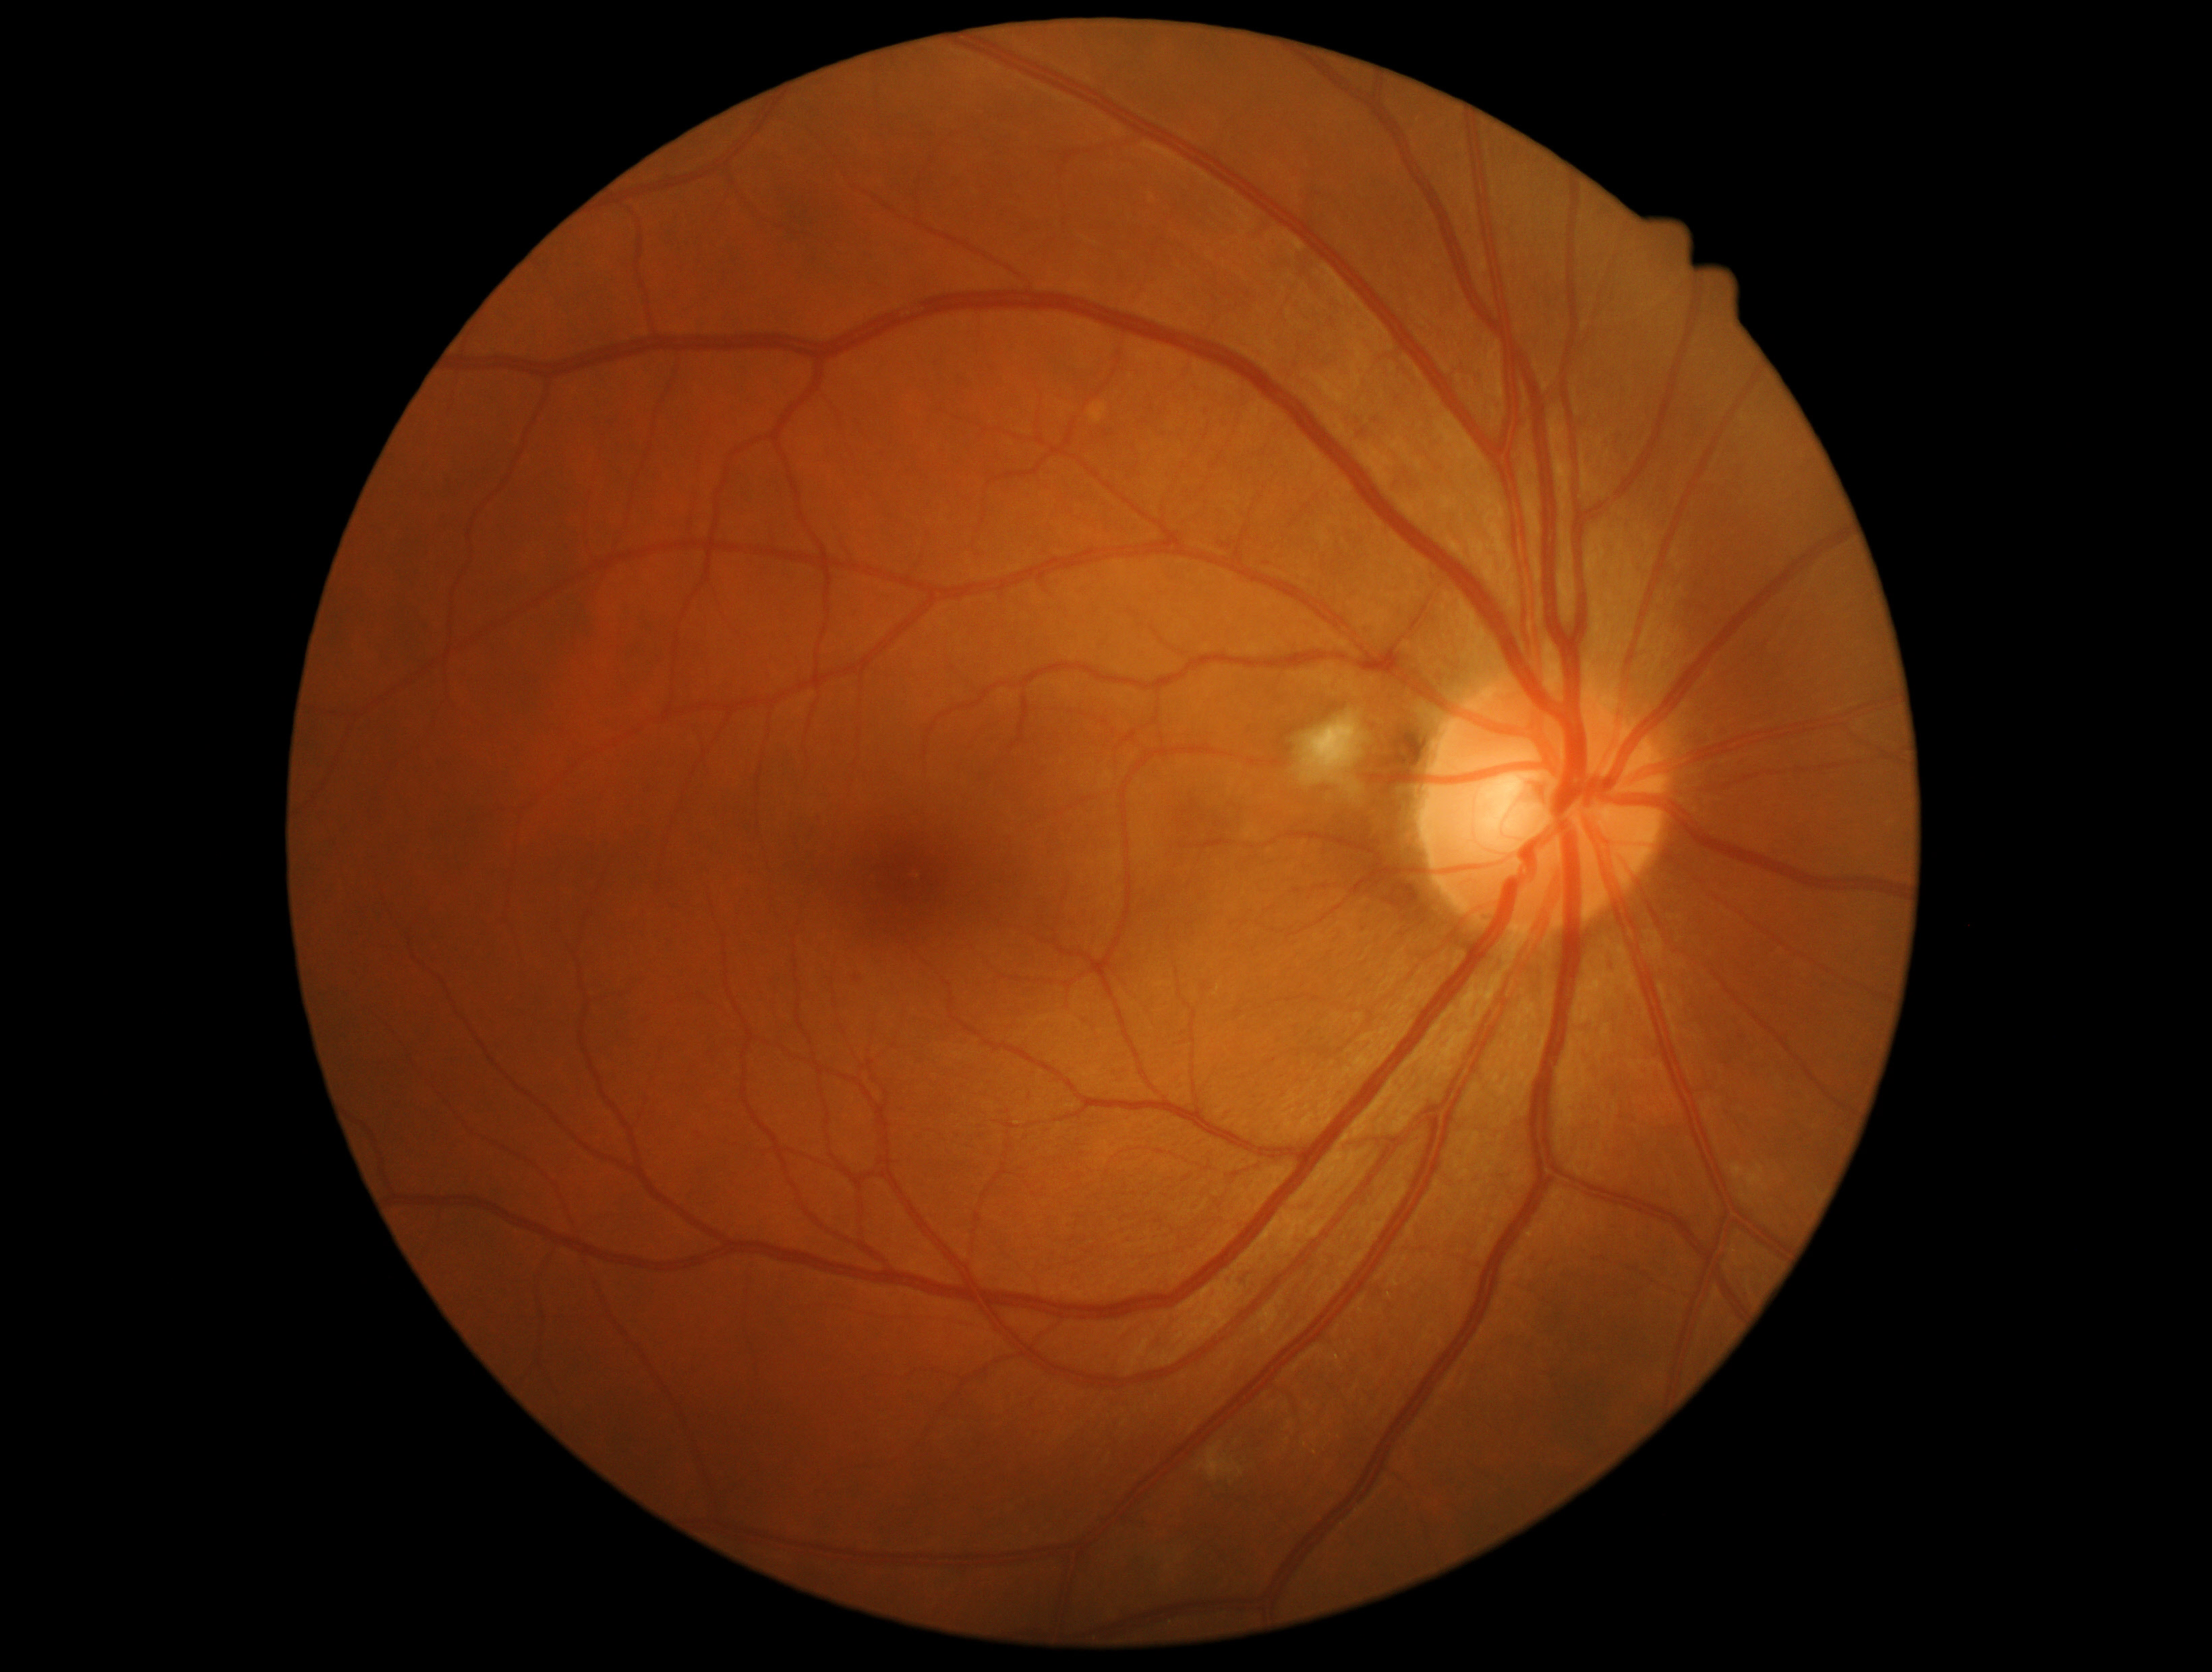 DR grade: 2